Retinal fundus photograph · acquired with a Remidio Fundus on Phone — 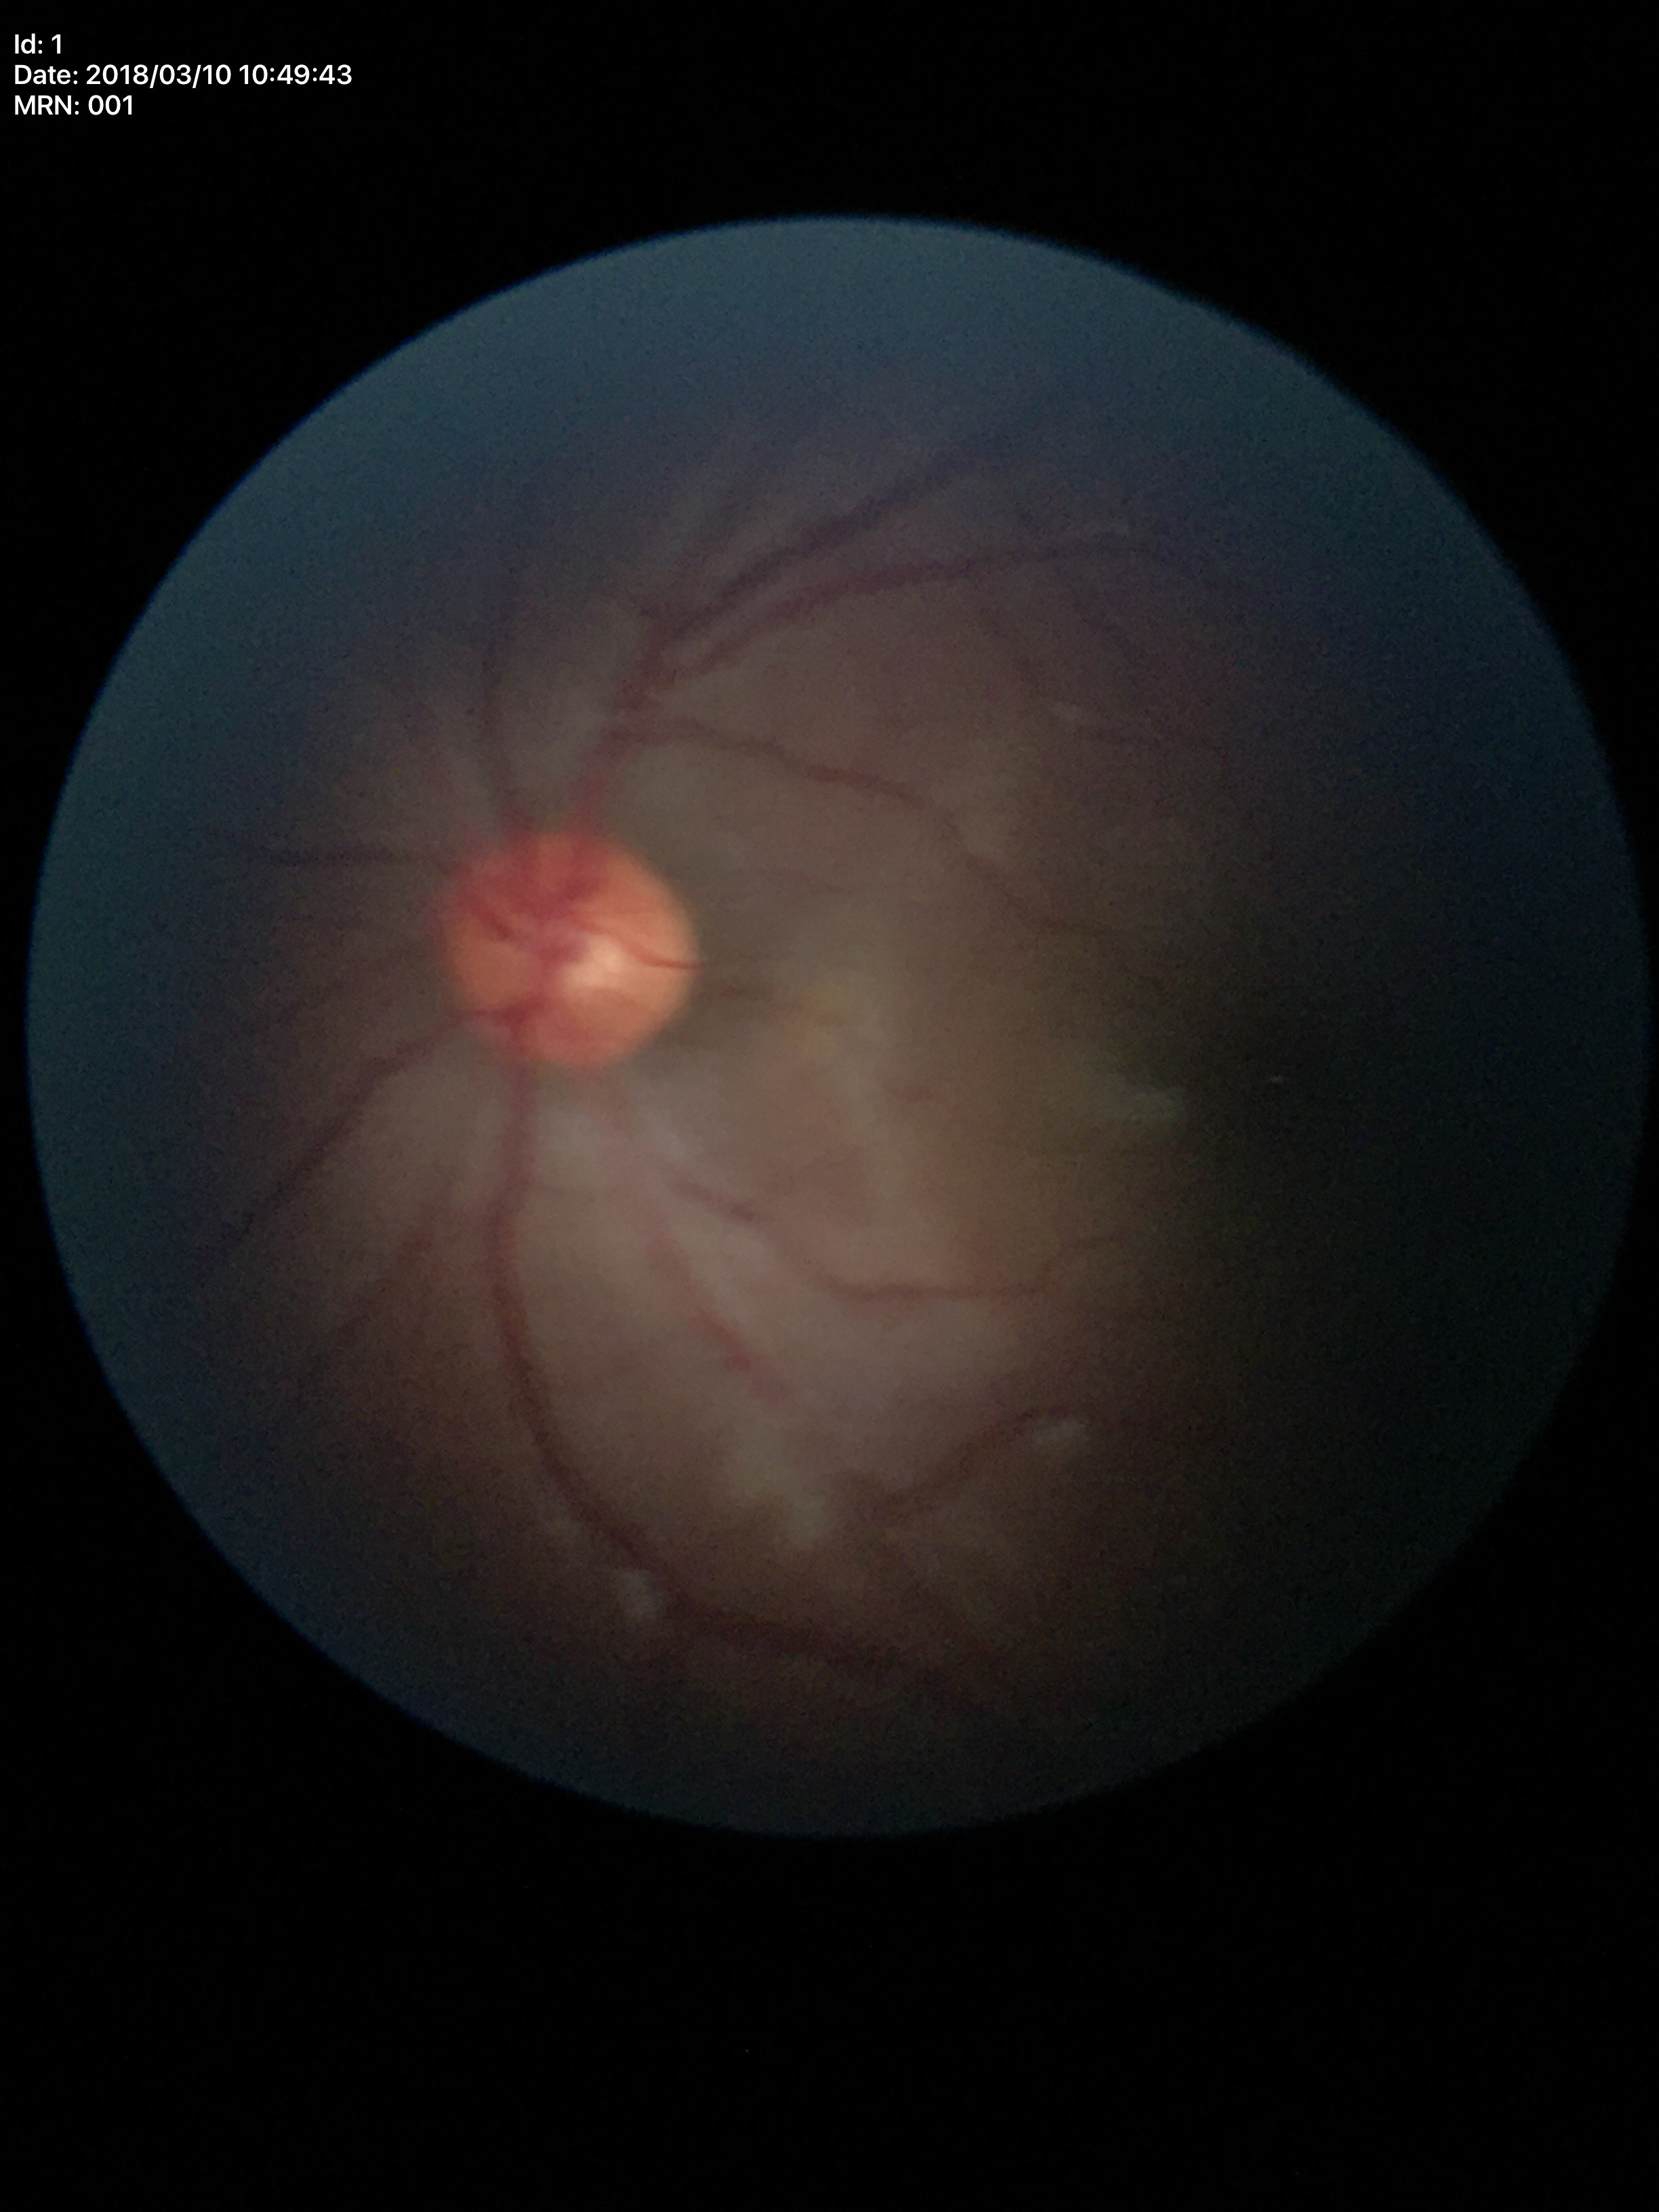
No signs of glaucoma (unanimous normal call). Vertical CDR is 0.42. Horizontal cup-disc ratio of 0.46.